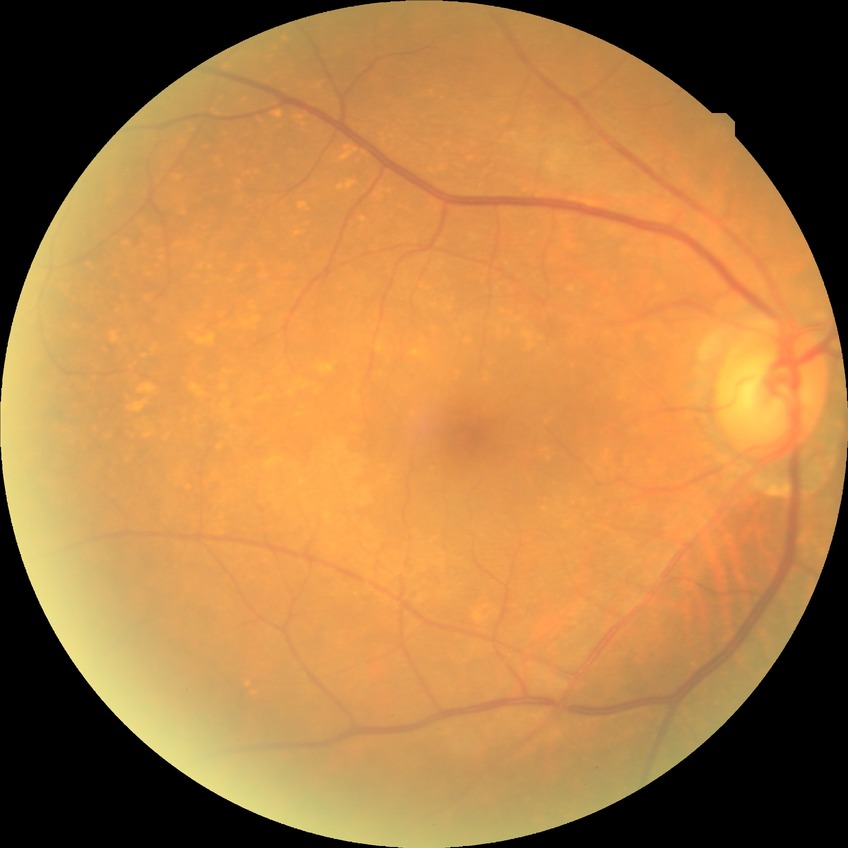 diabetic retinopathy (DR) = no diabetic retinopathy (NDR).